45° field of view · image size 2352x1568:
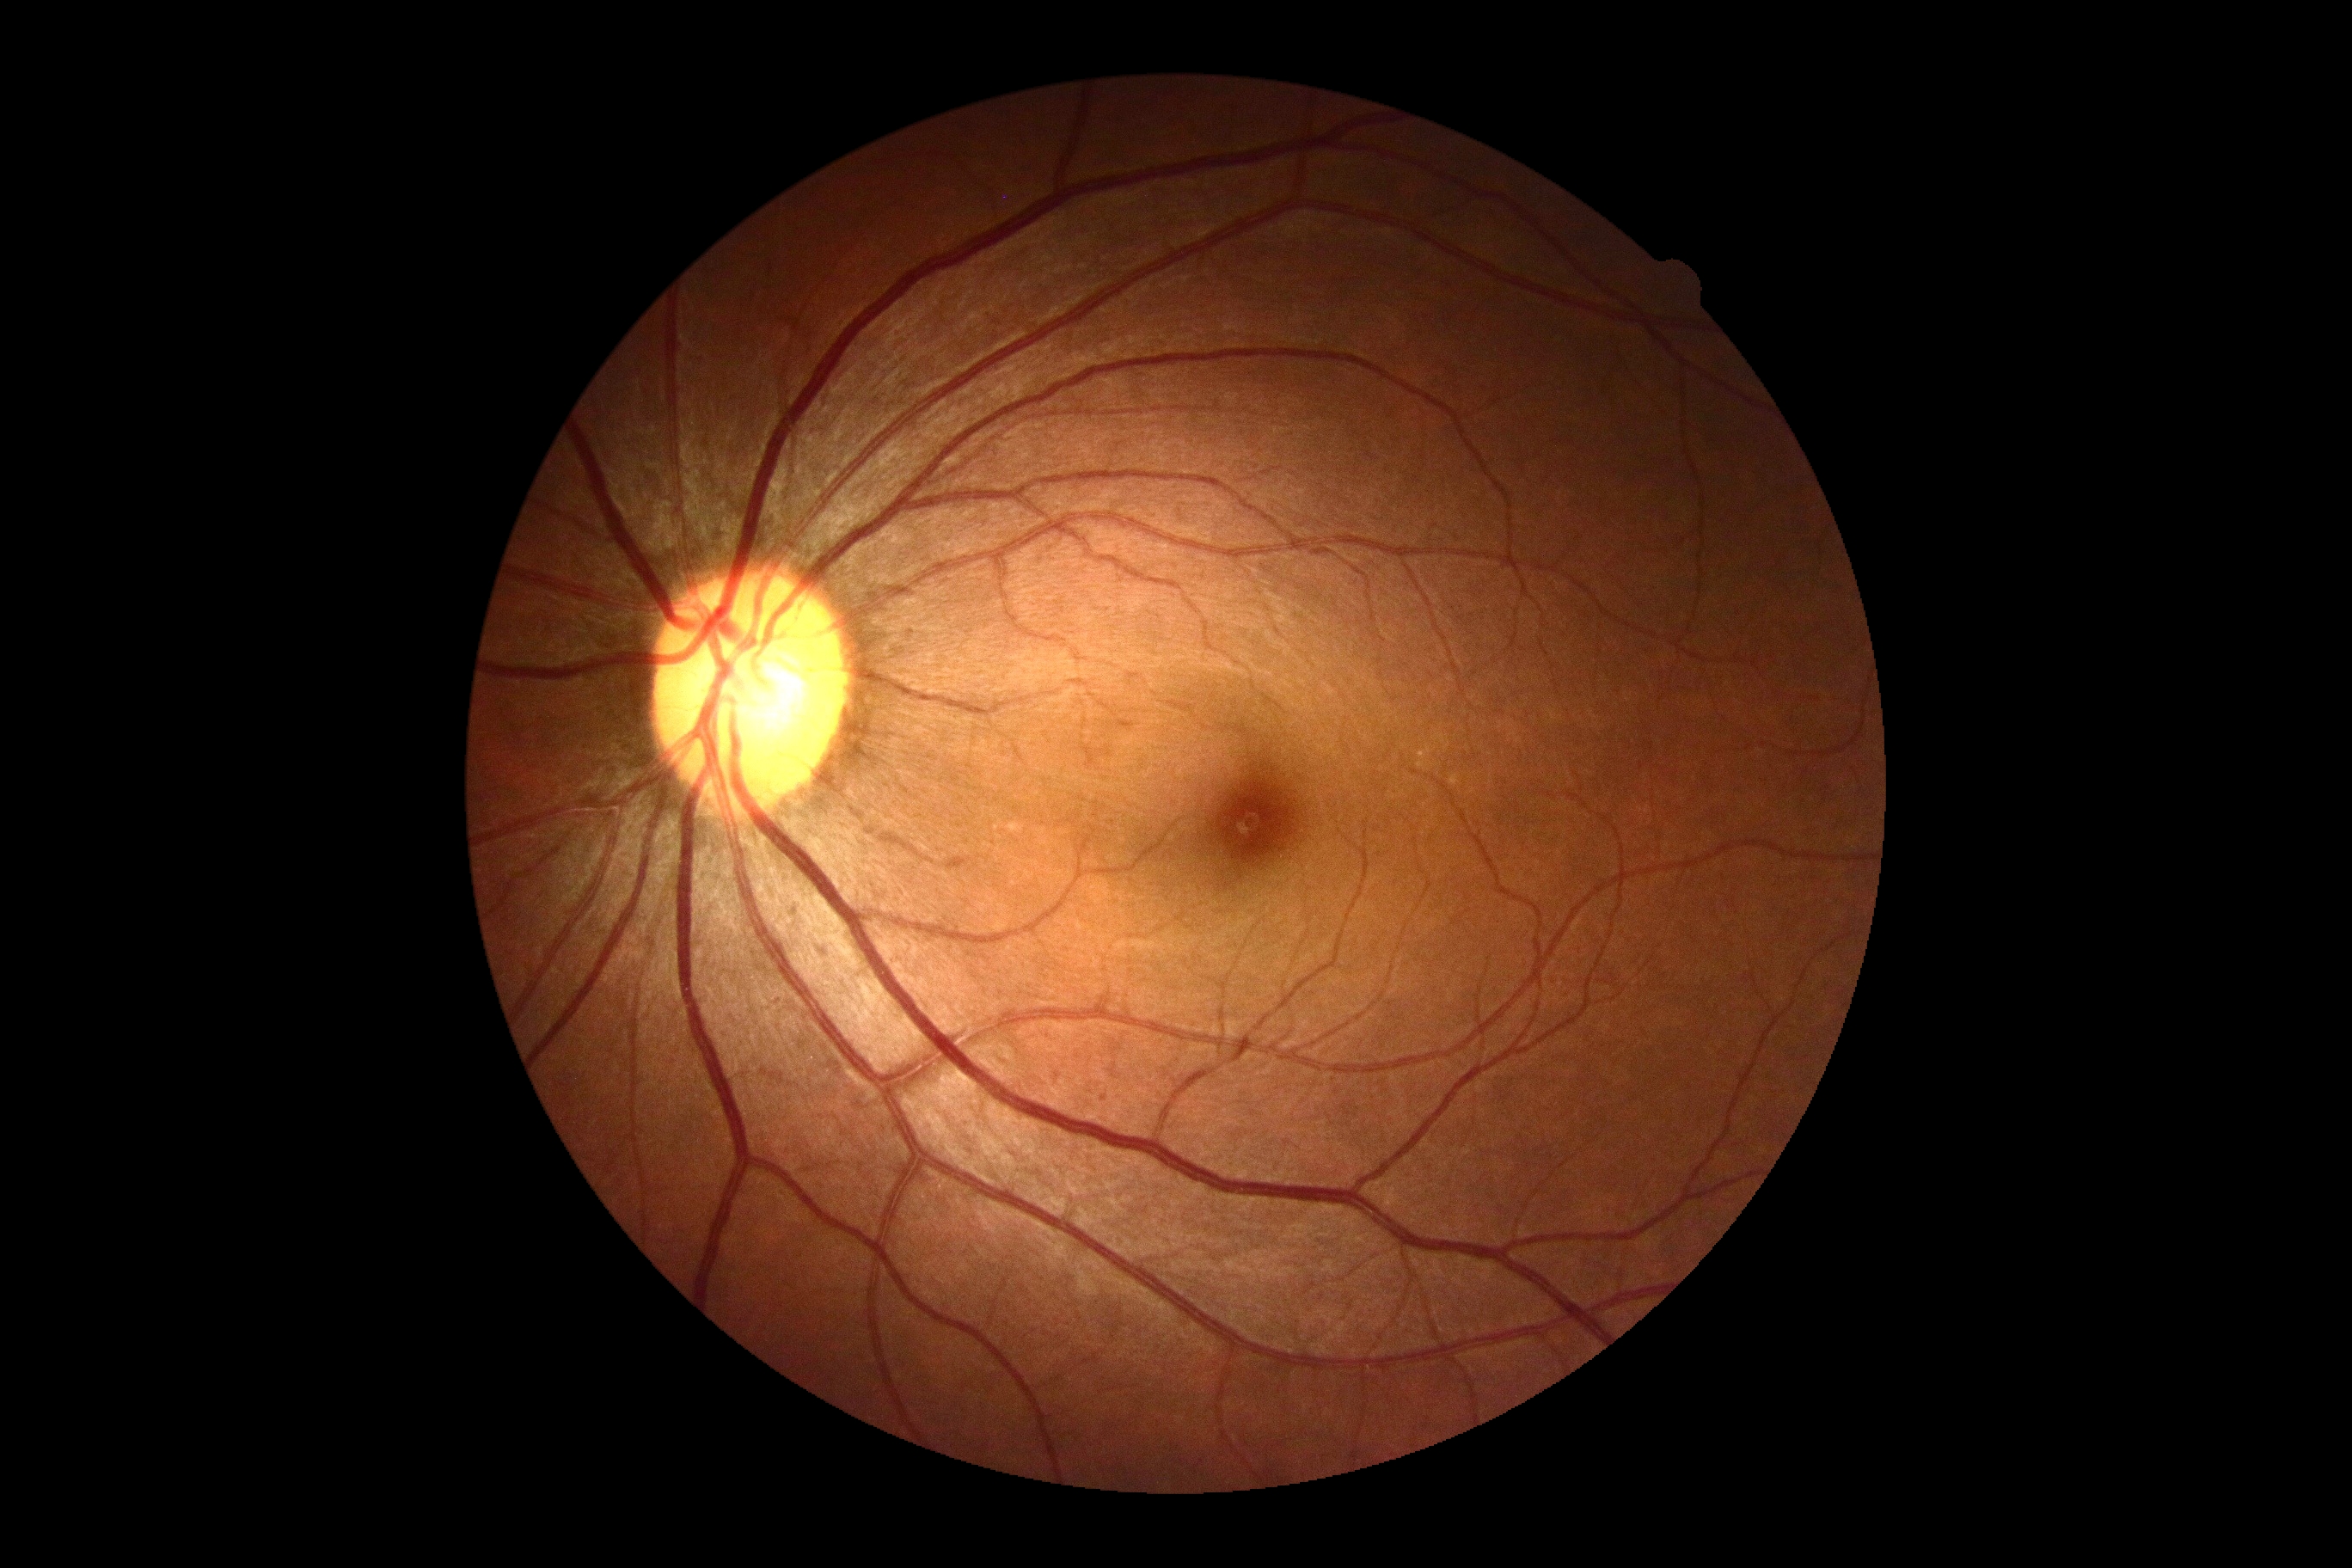
Diabetic retinopathy severity is grade 0 (no apparent retinopathy).